45° field of view — 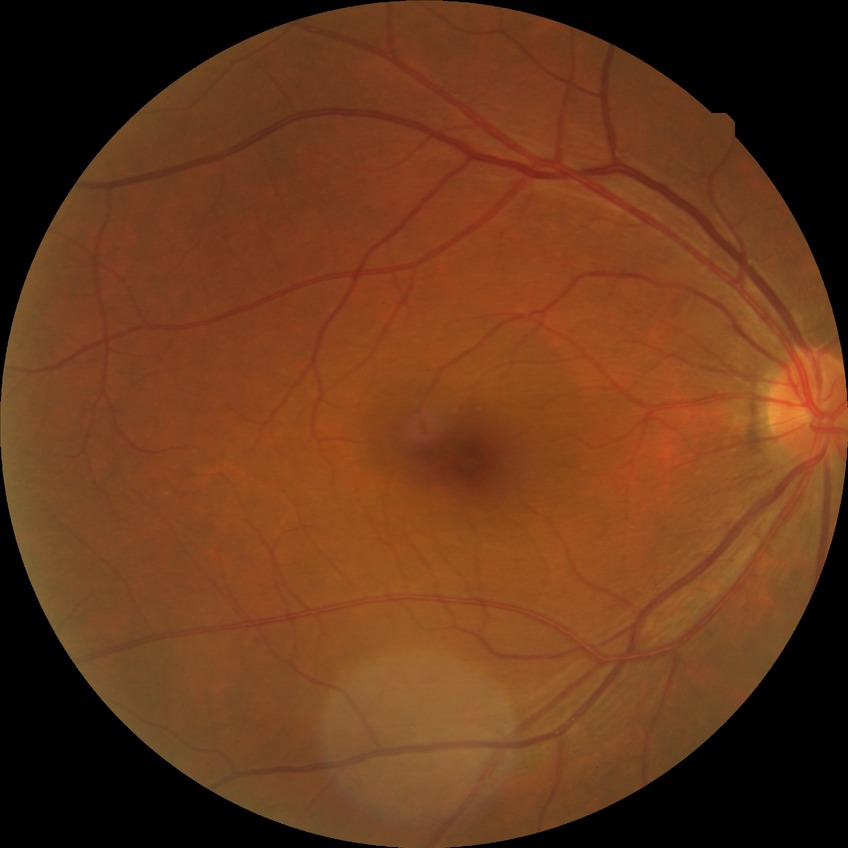 Diabetic retinopathy (DR) is no diabetic retinopathy (NDR).